FOV: 45 degrees.
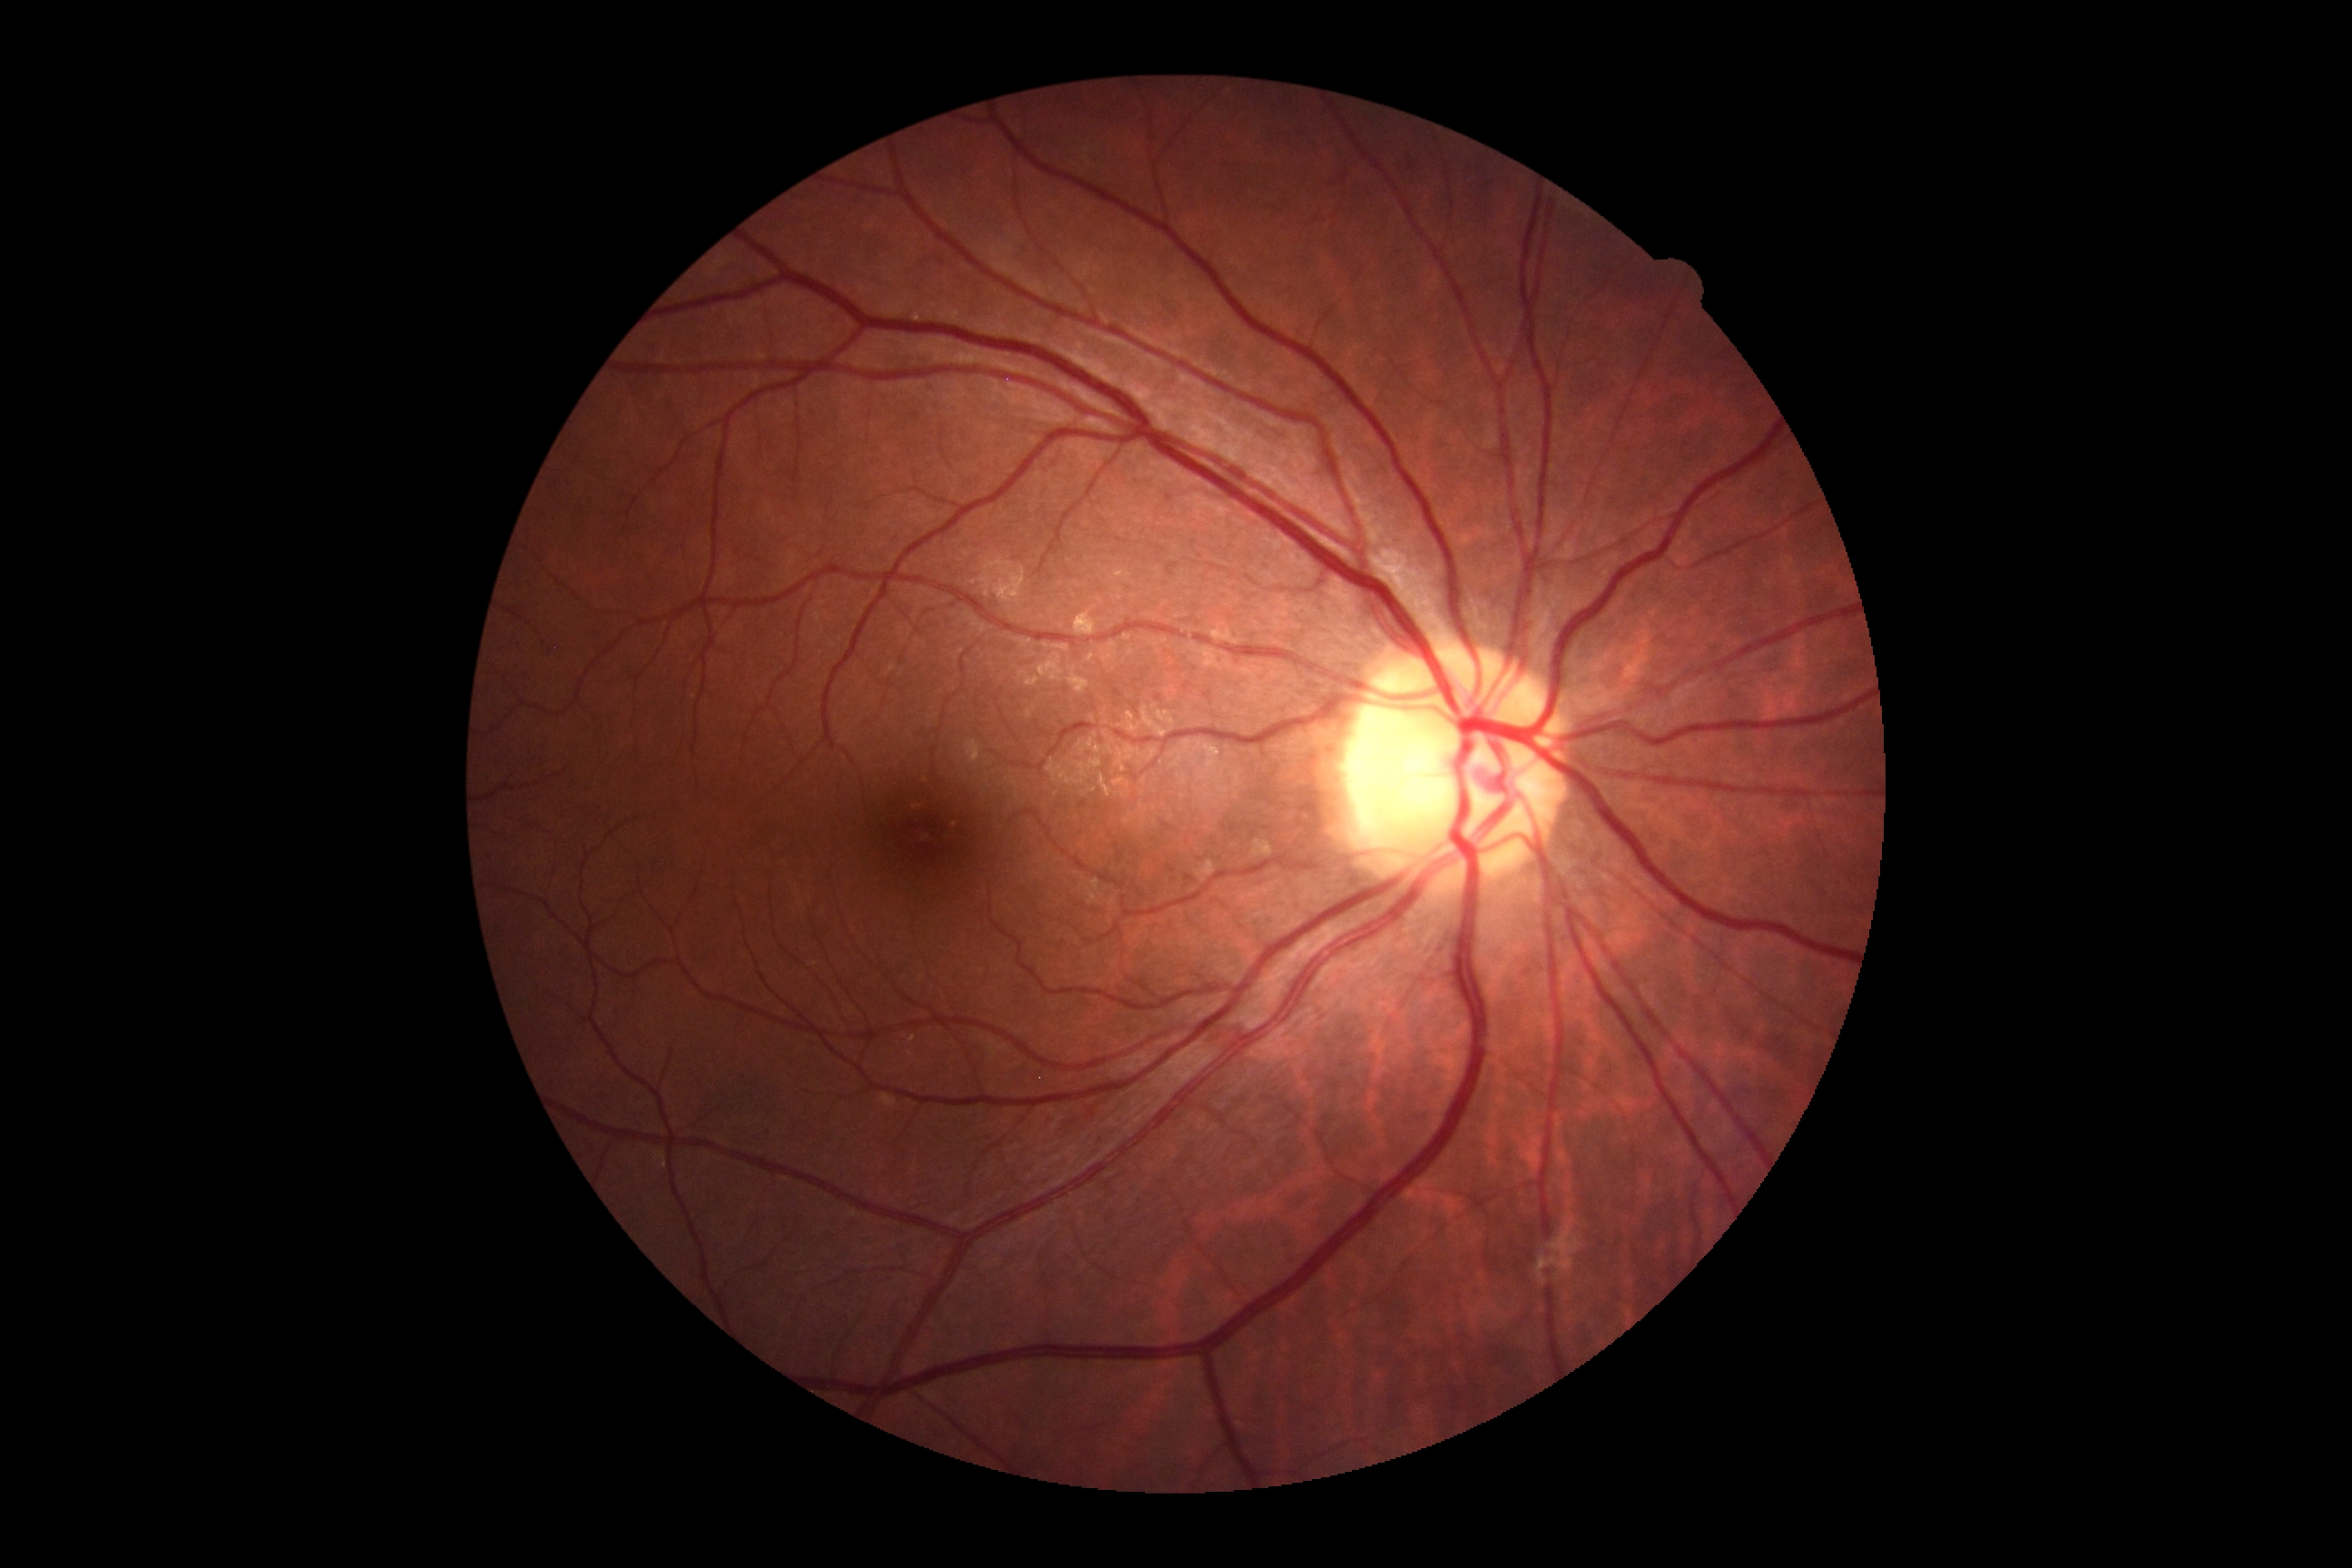

{
  "dr_grade": "no apparent retinopathy (0)"
}